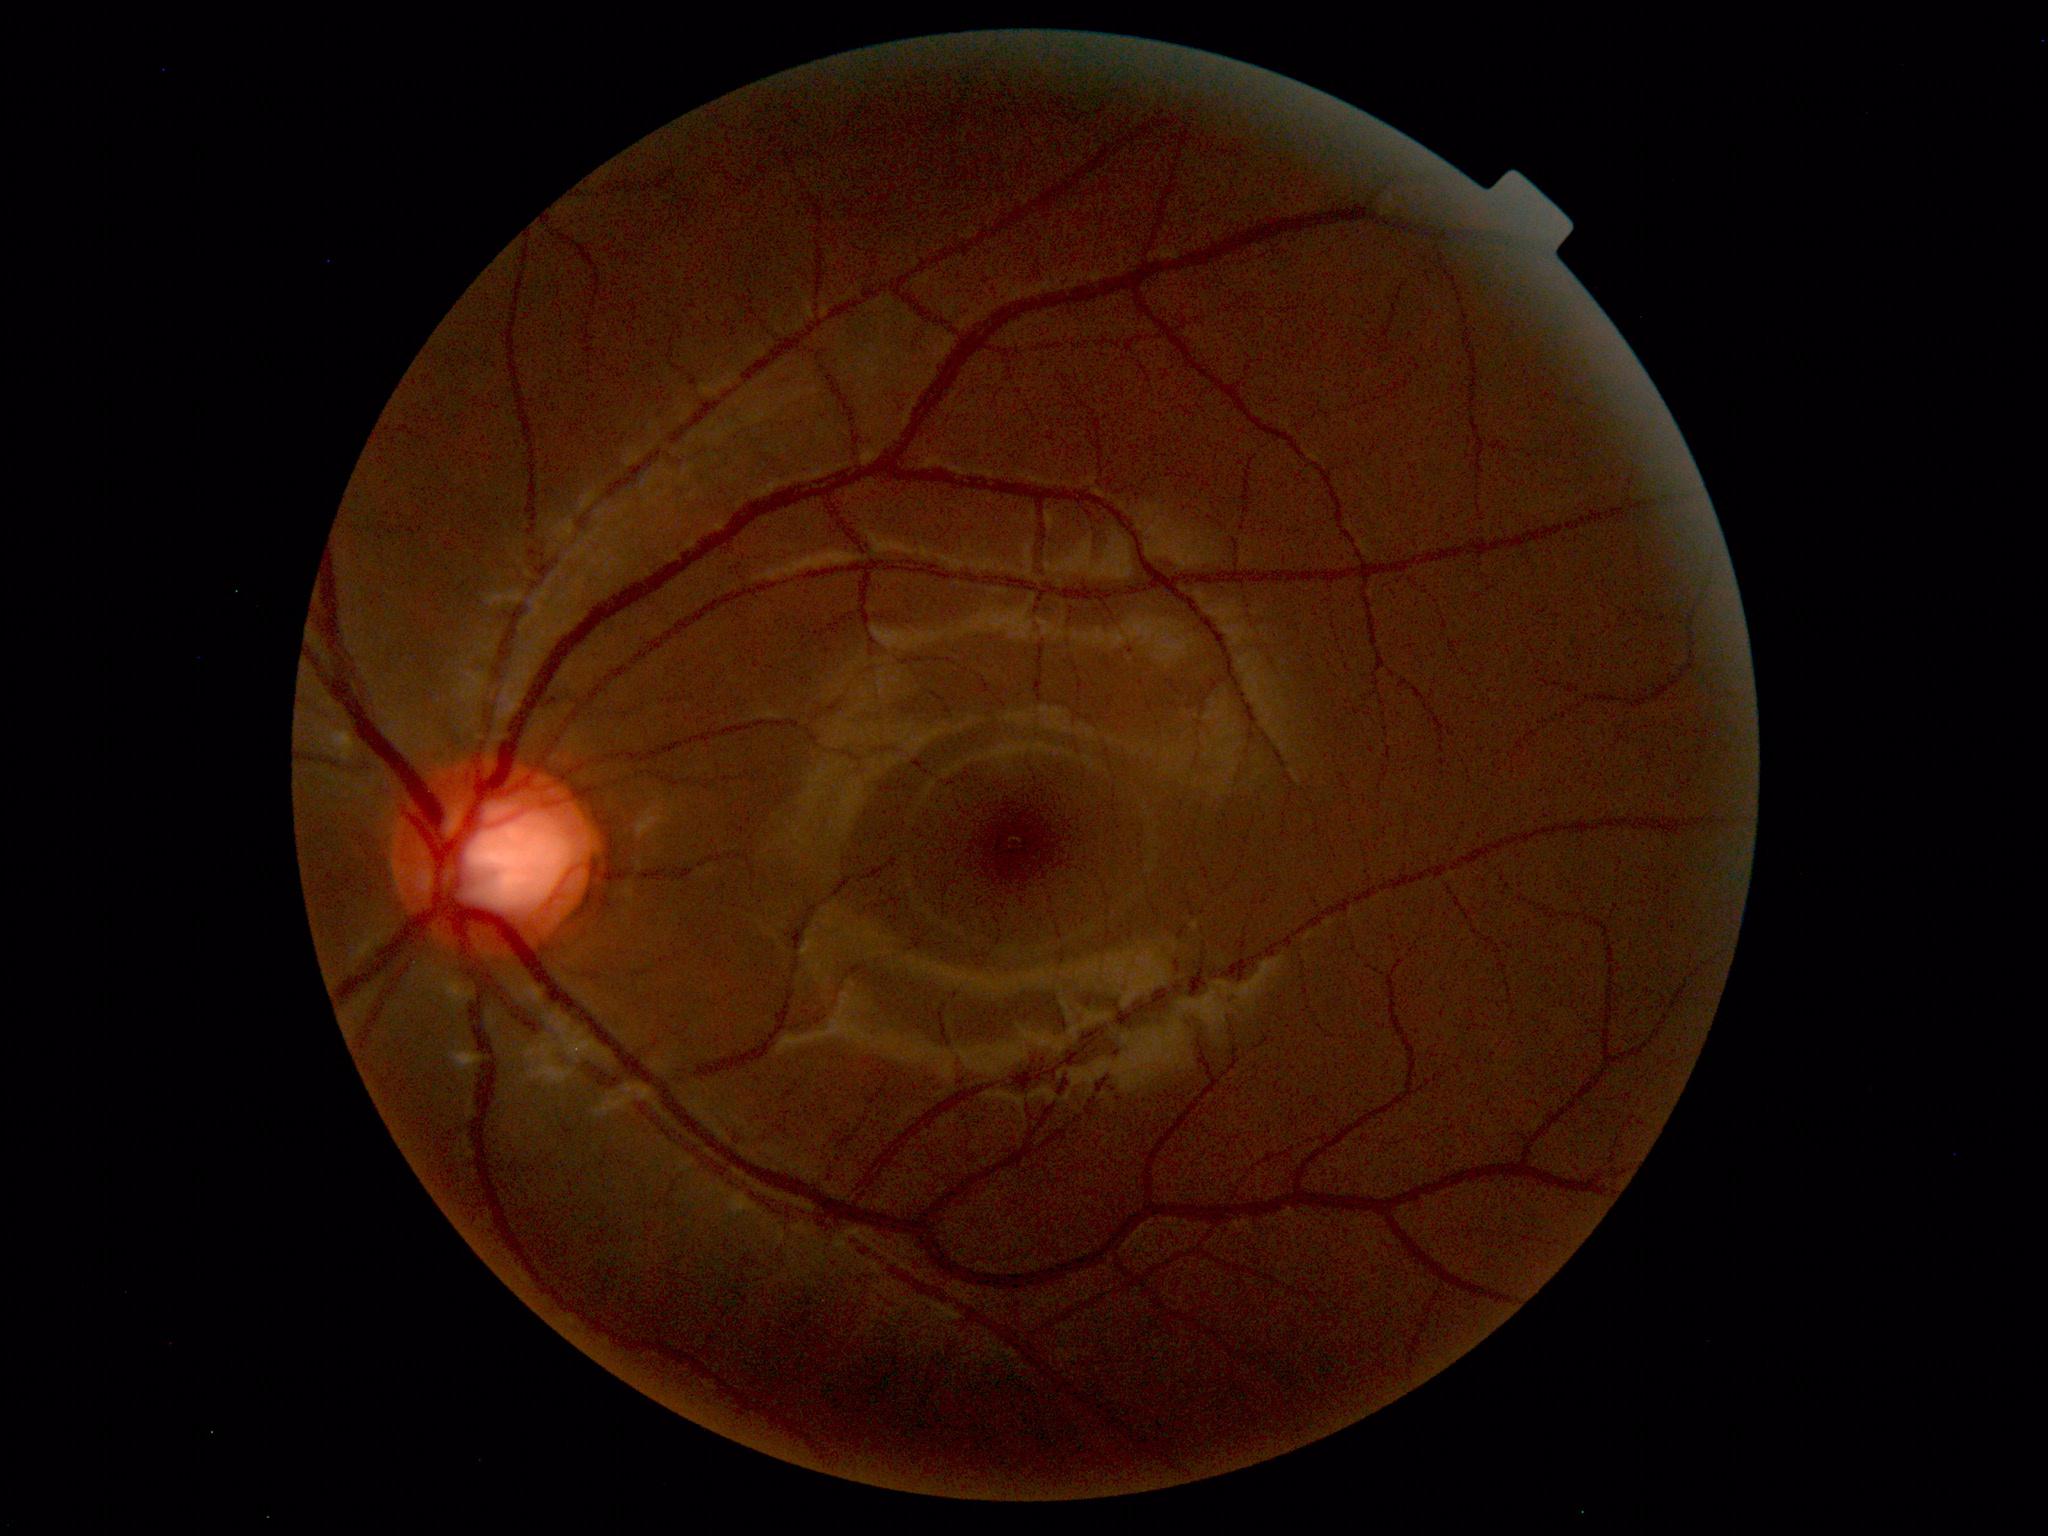

Findings: no abnormalities.